640x480; pediatric wide-field fundus photograph:
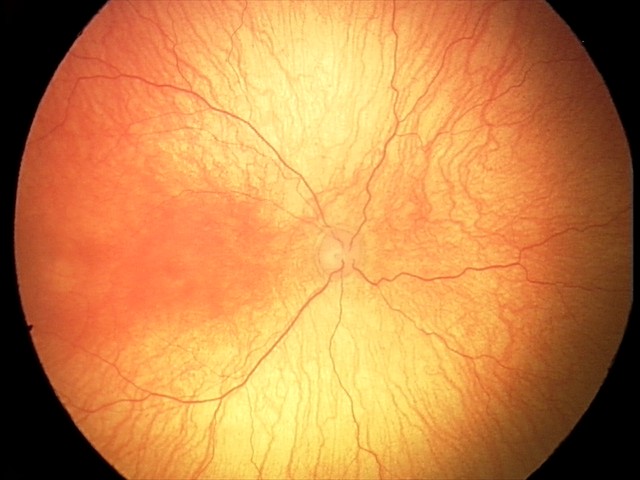 Plus disease was diagnosed. Screening series with aggressive retinopathy of prematurity (A-ROP).